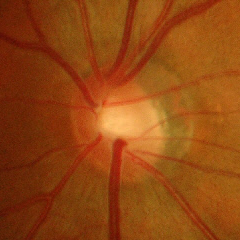

Glaucoma diagnosis: advanced glaucomatous optic neuropathy.